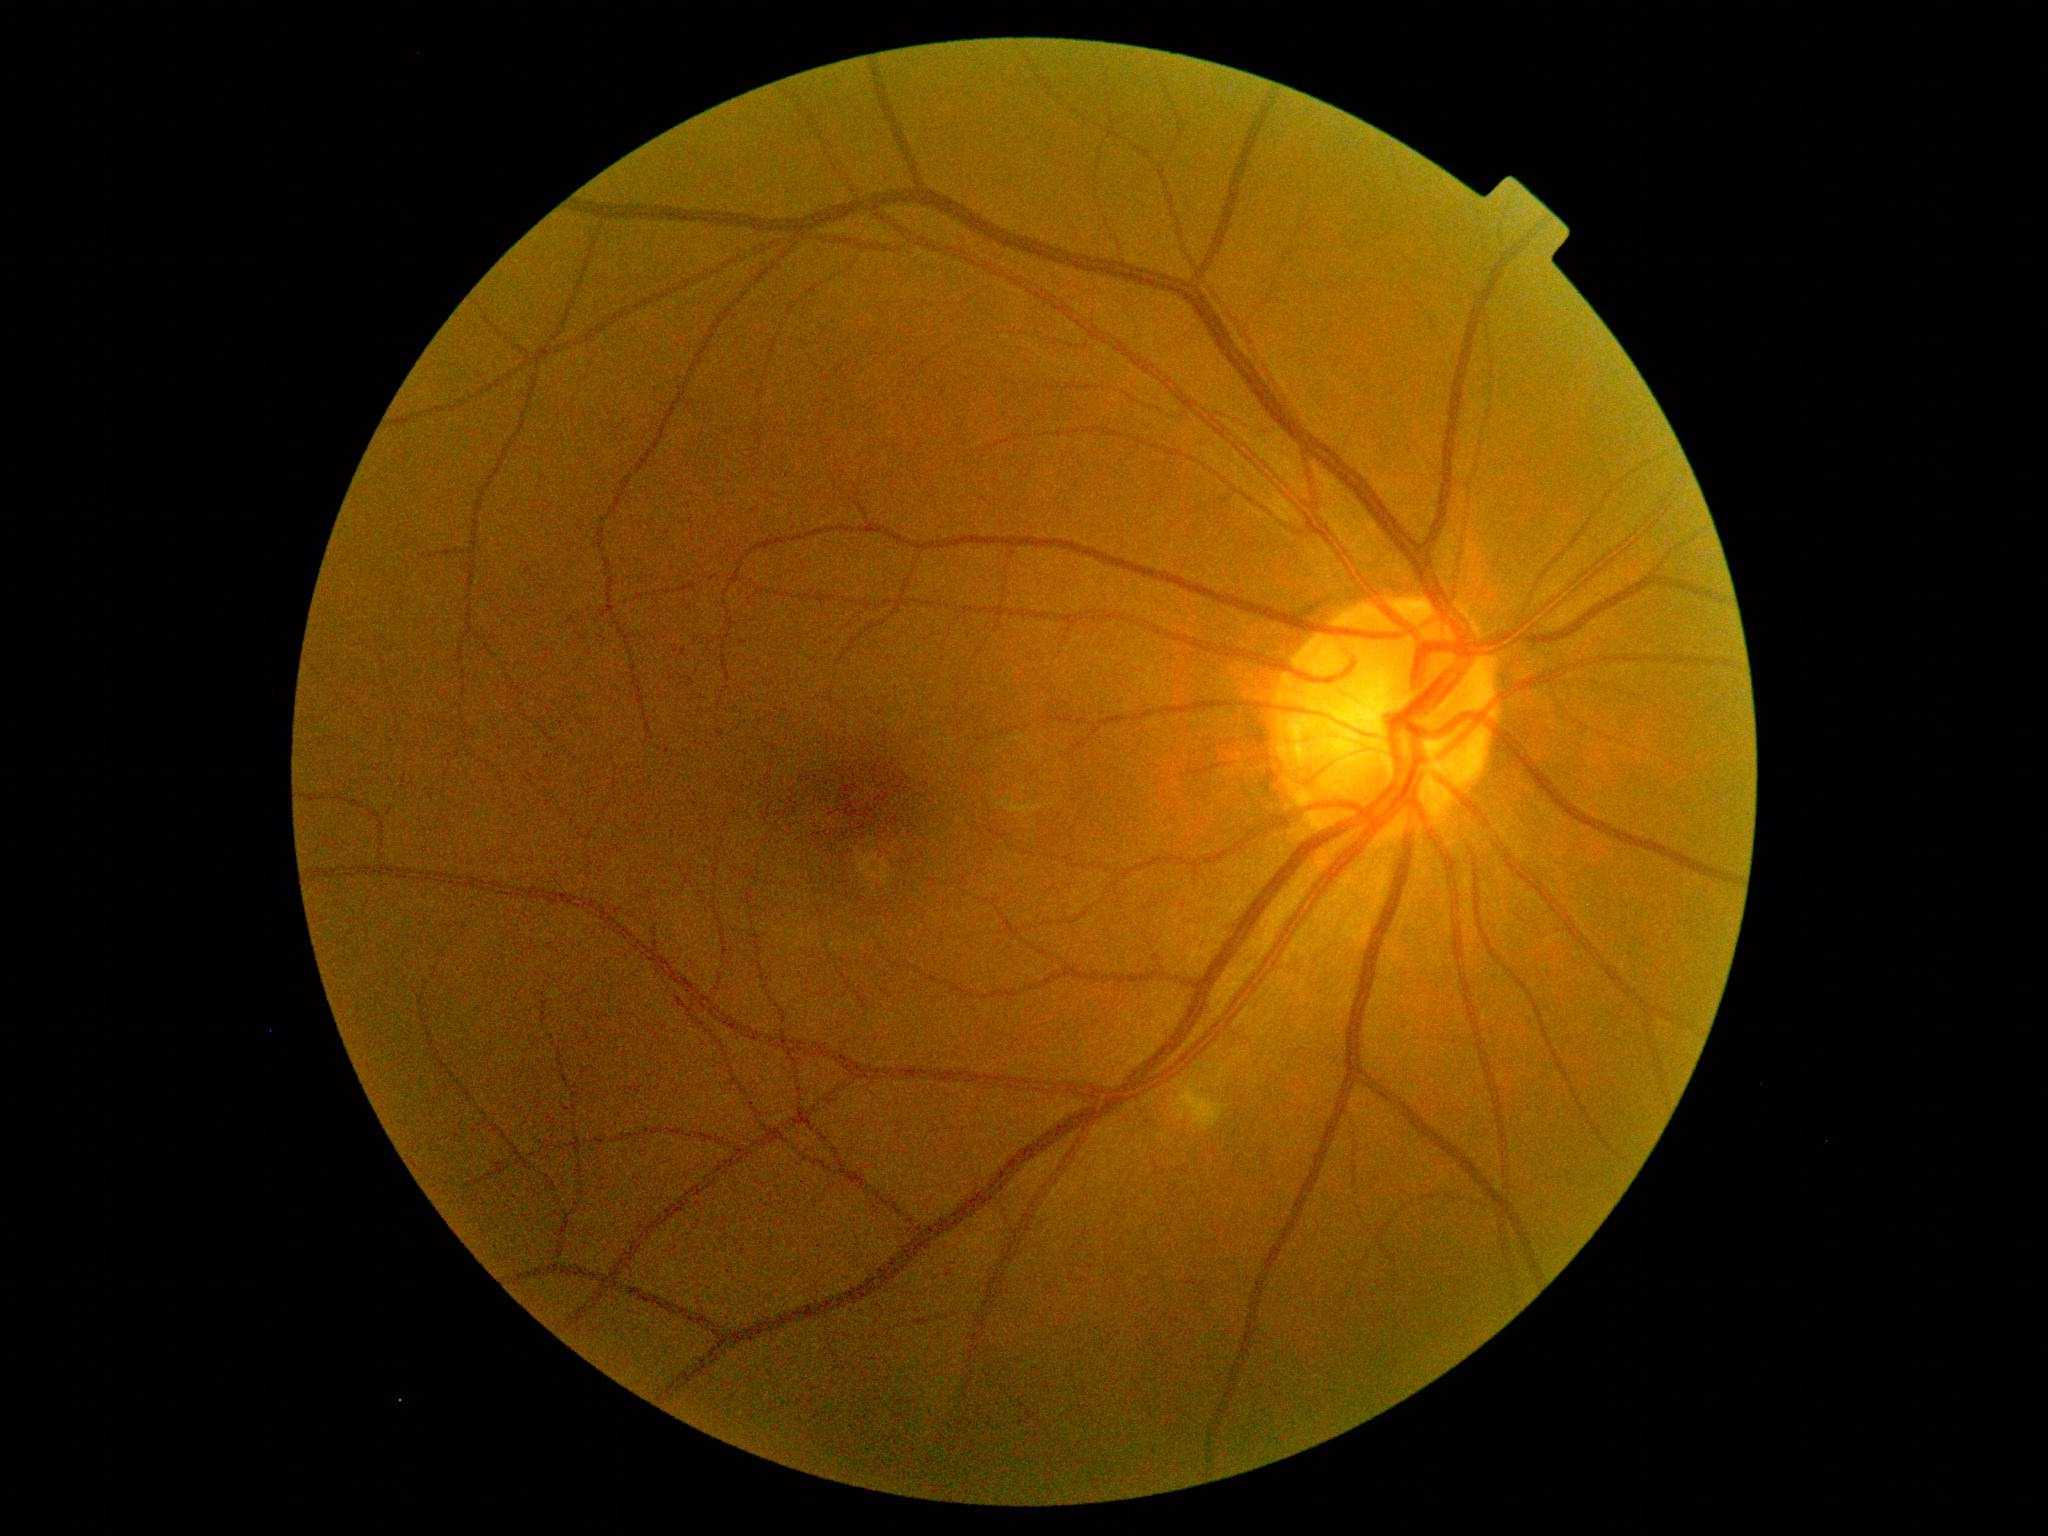
DR severity is grade 2 (moderate NPDR).